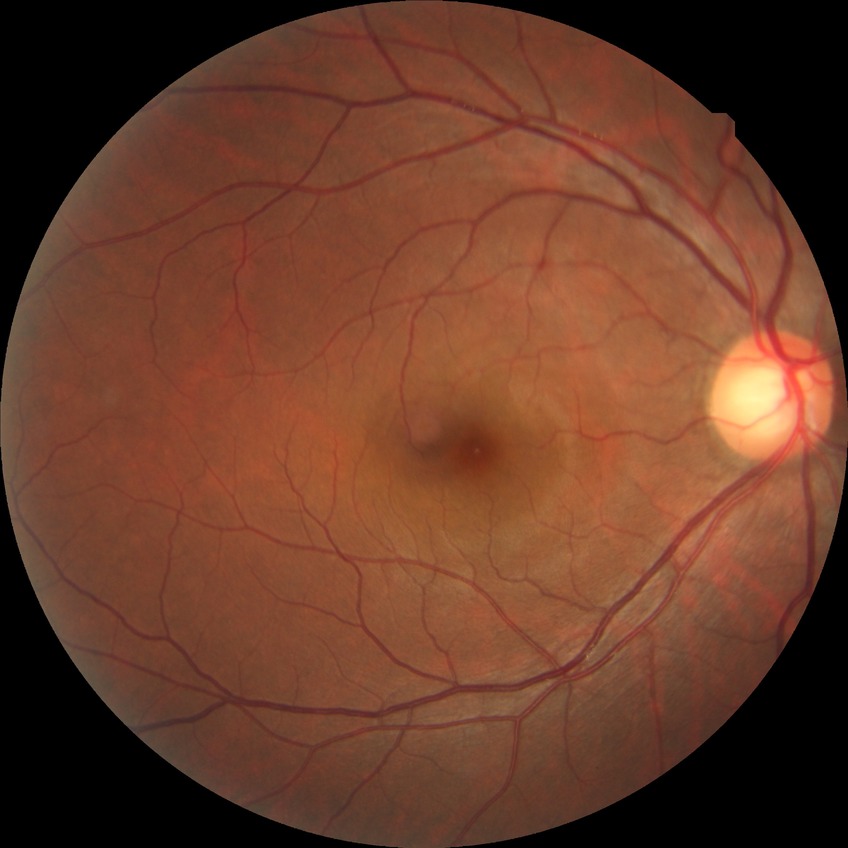
Davis DR grade: NDR.